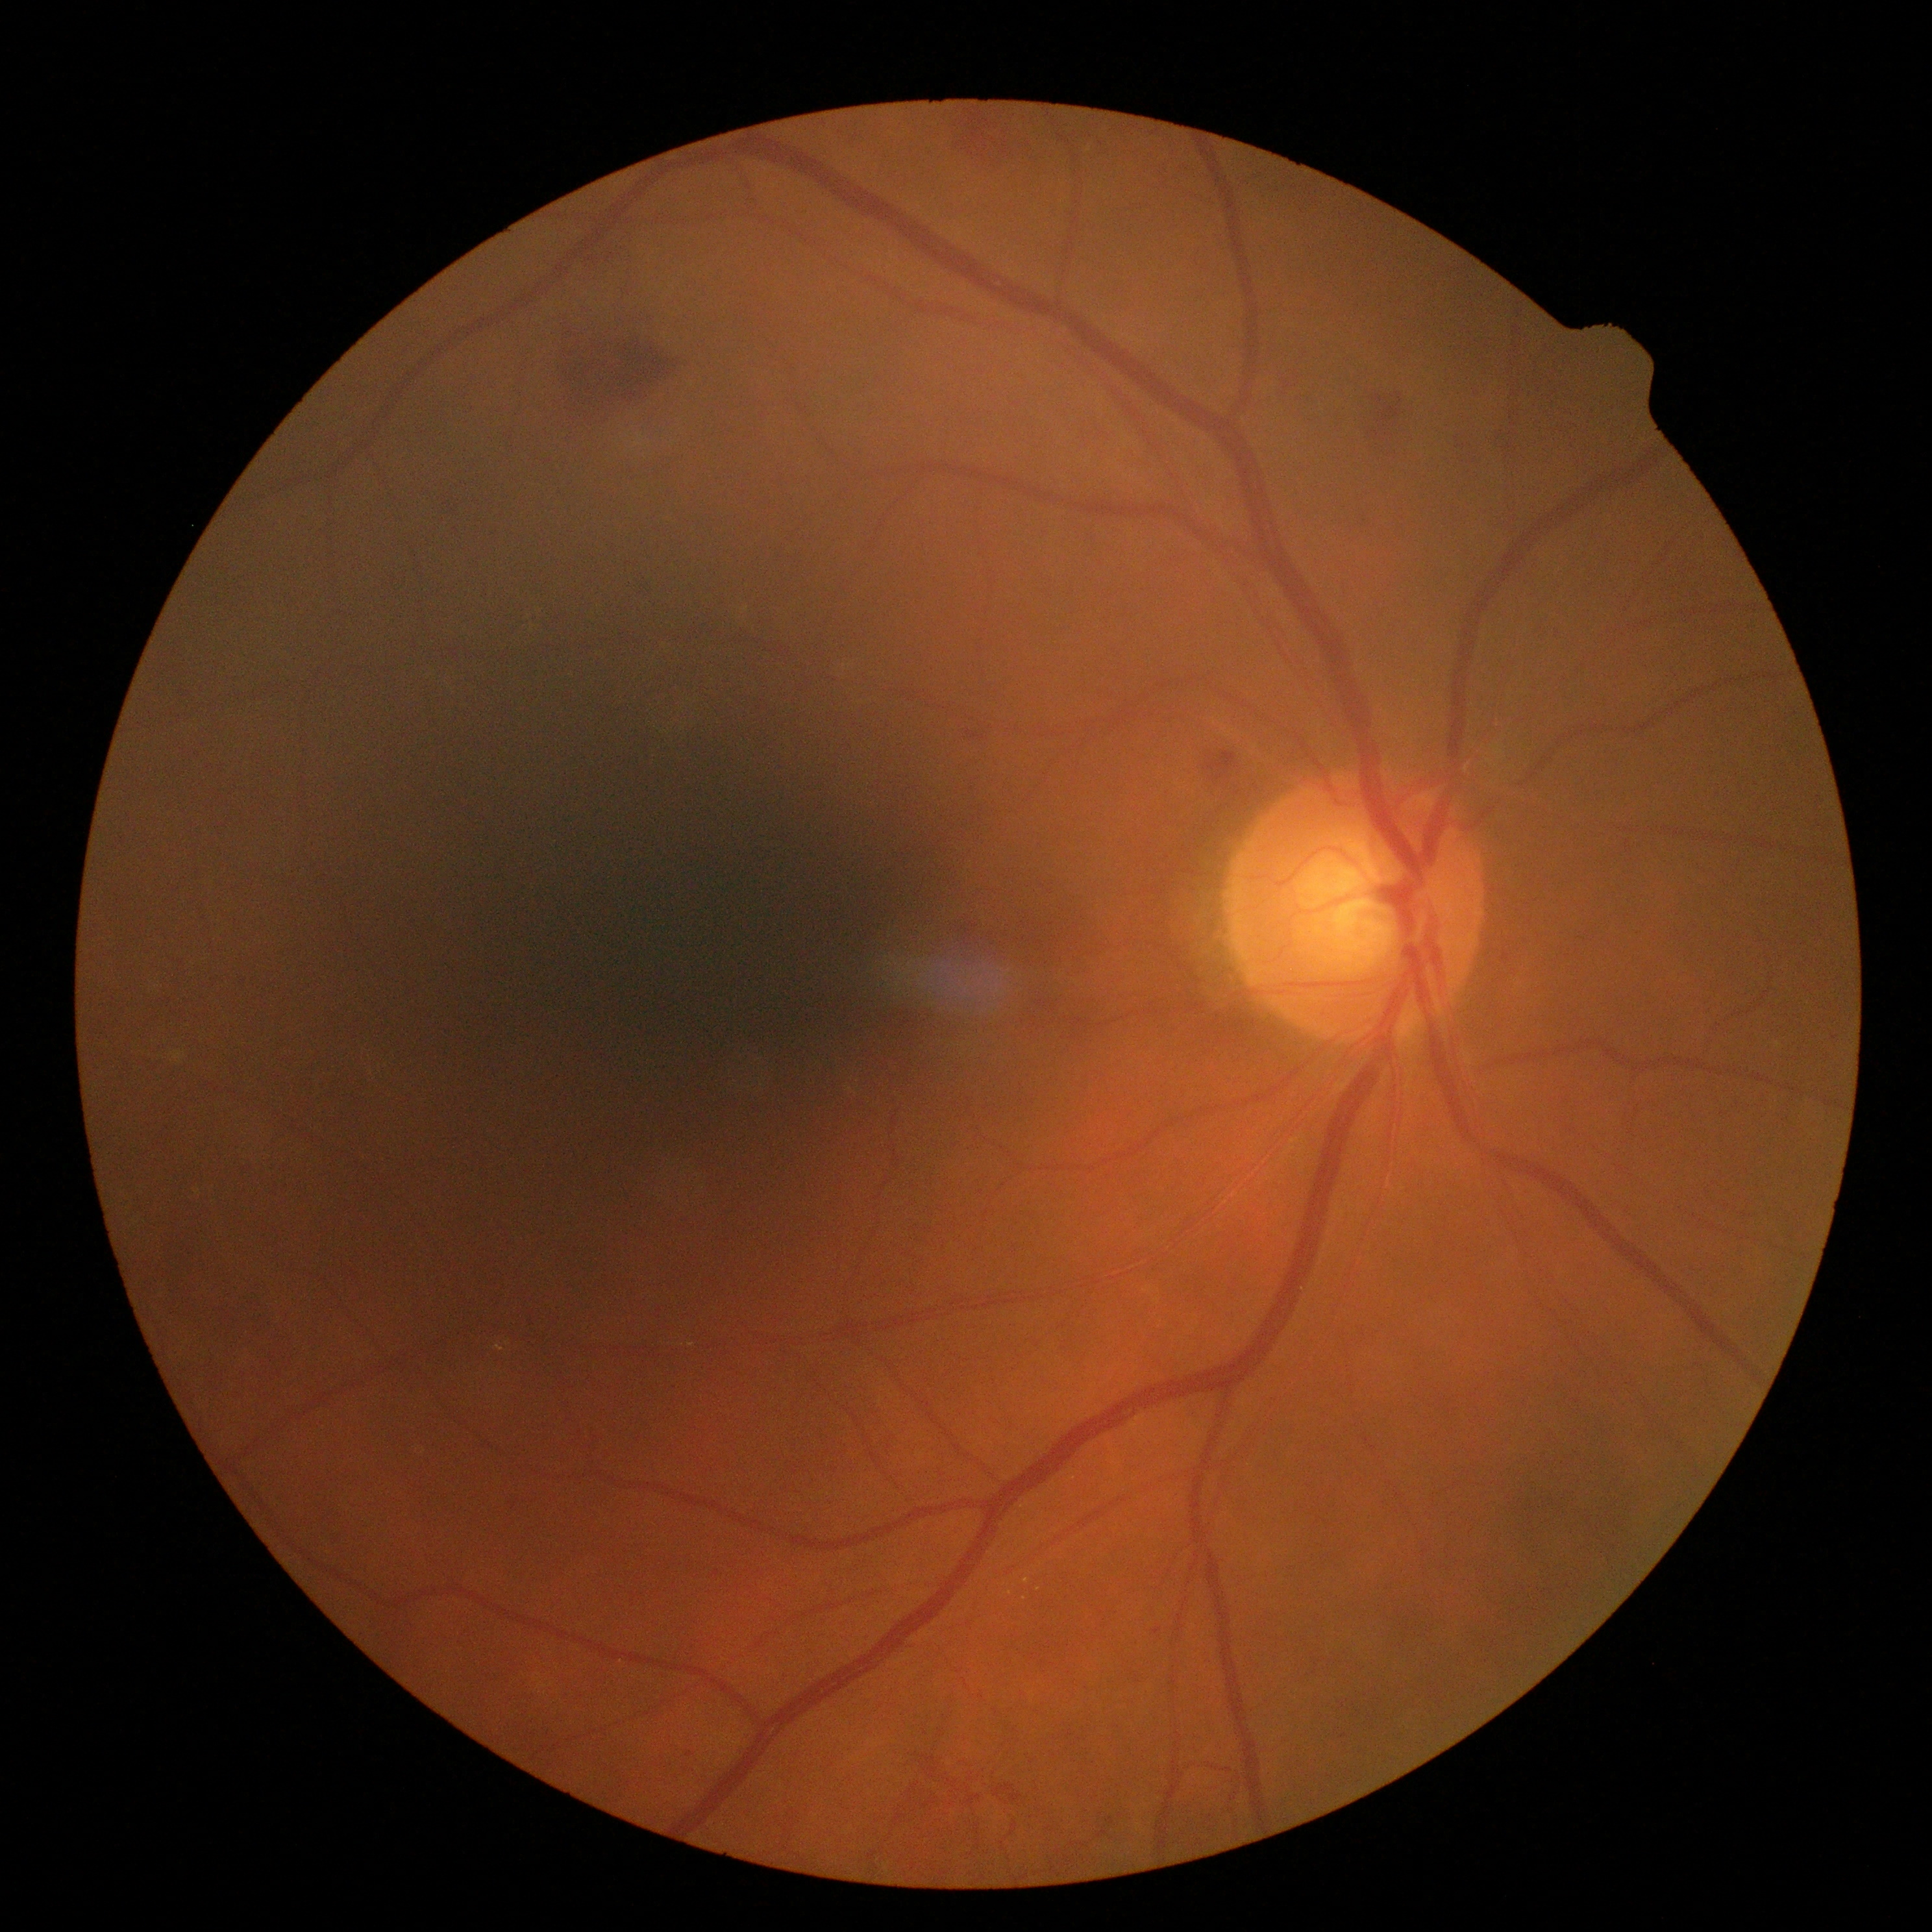
diabetic retinopathy grade@2; DR class@non-proliferative diabetic retinopathy.